Image size 1932x1916: 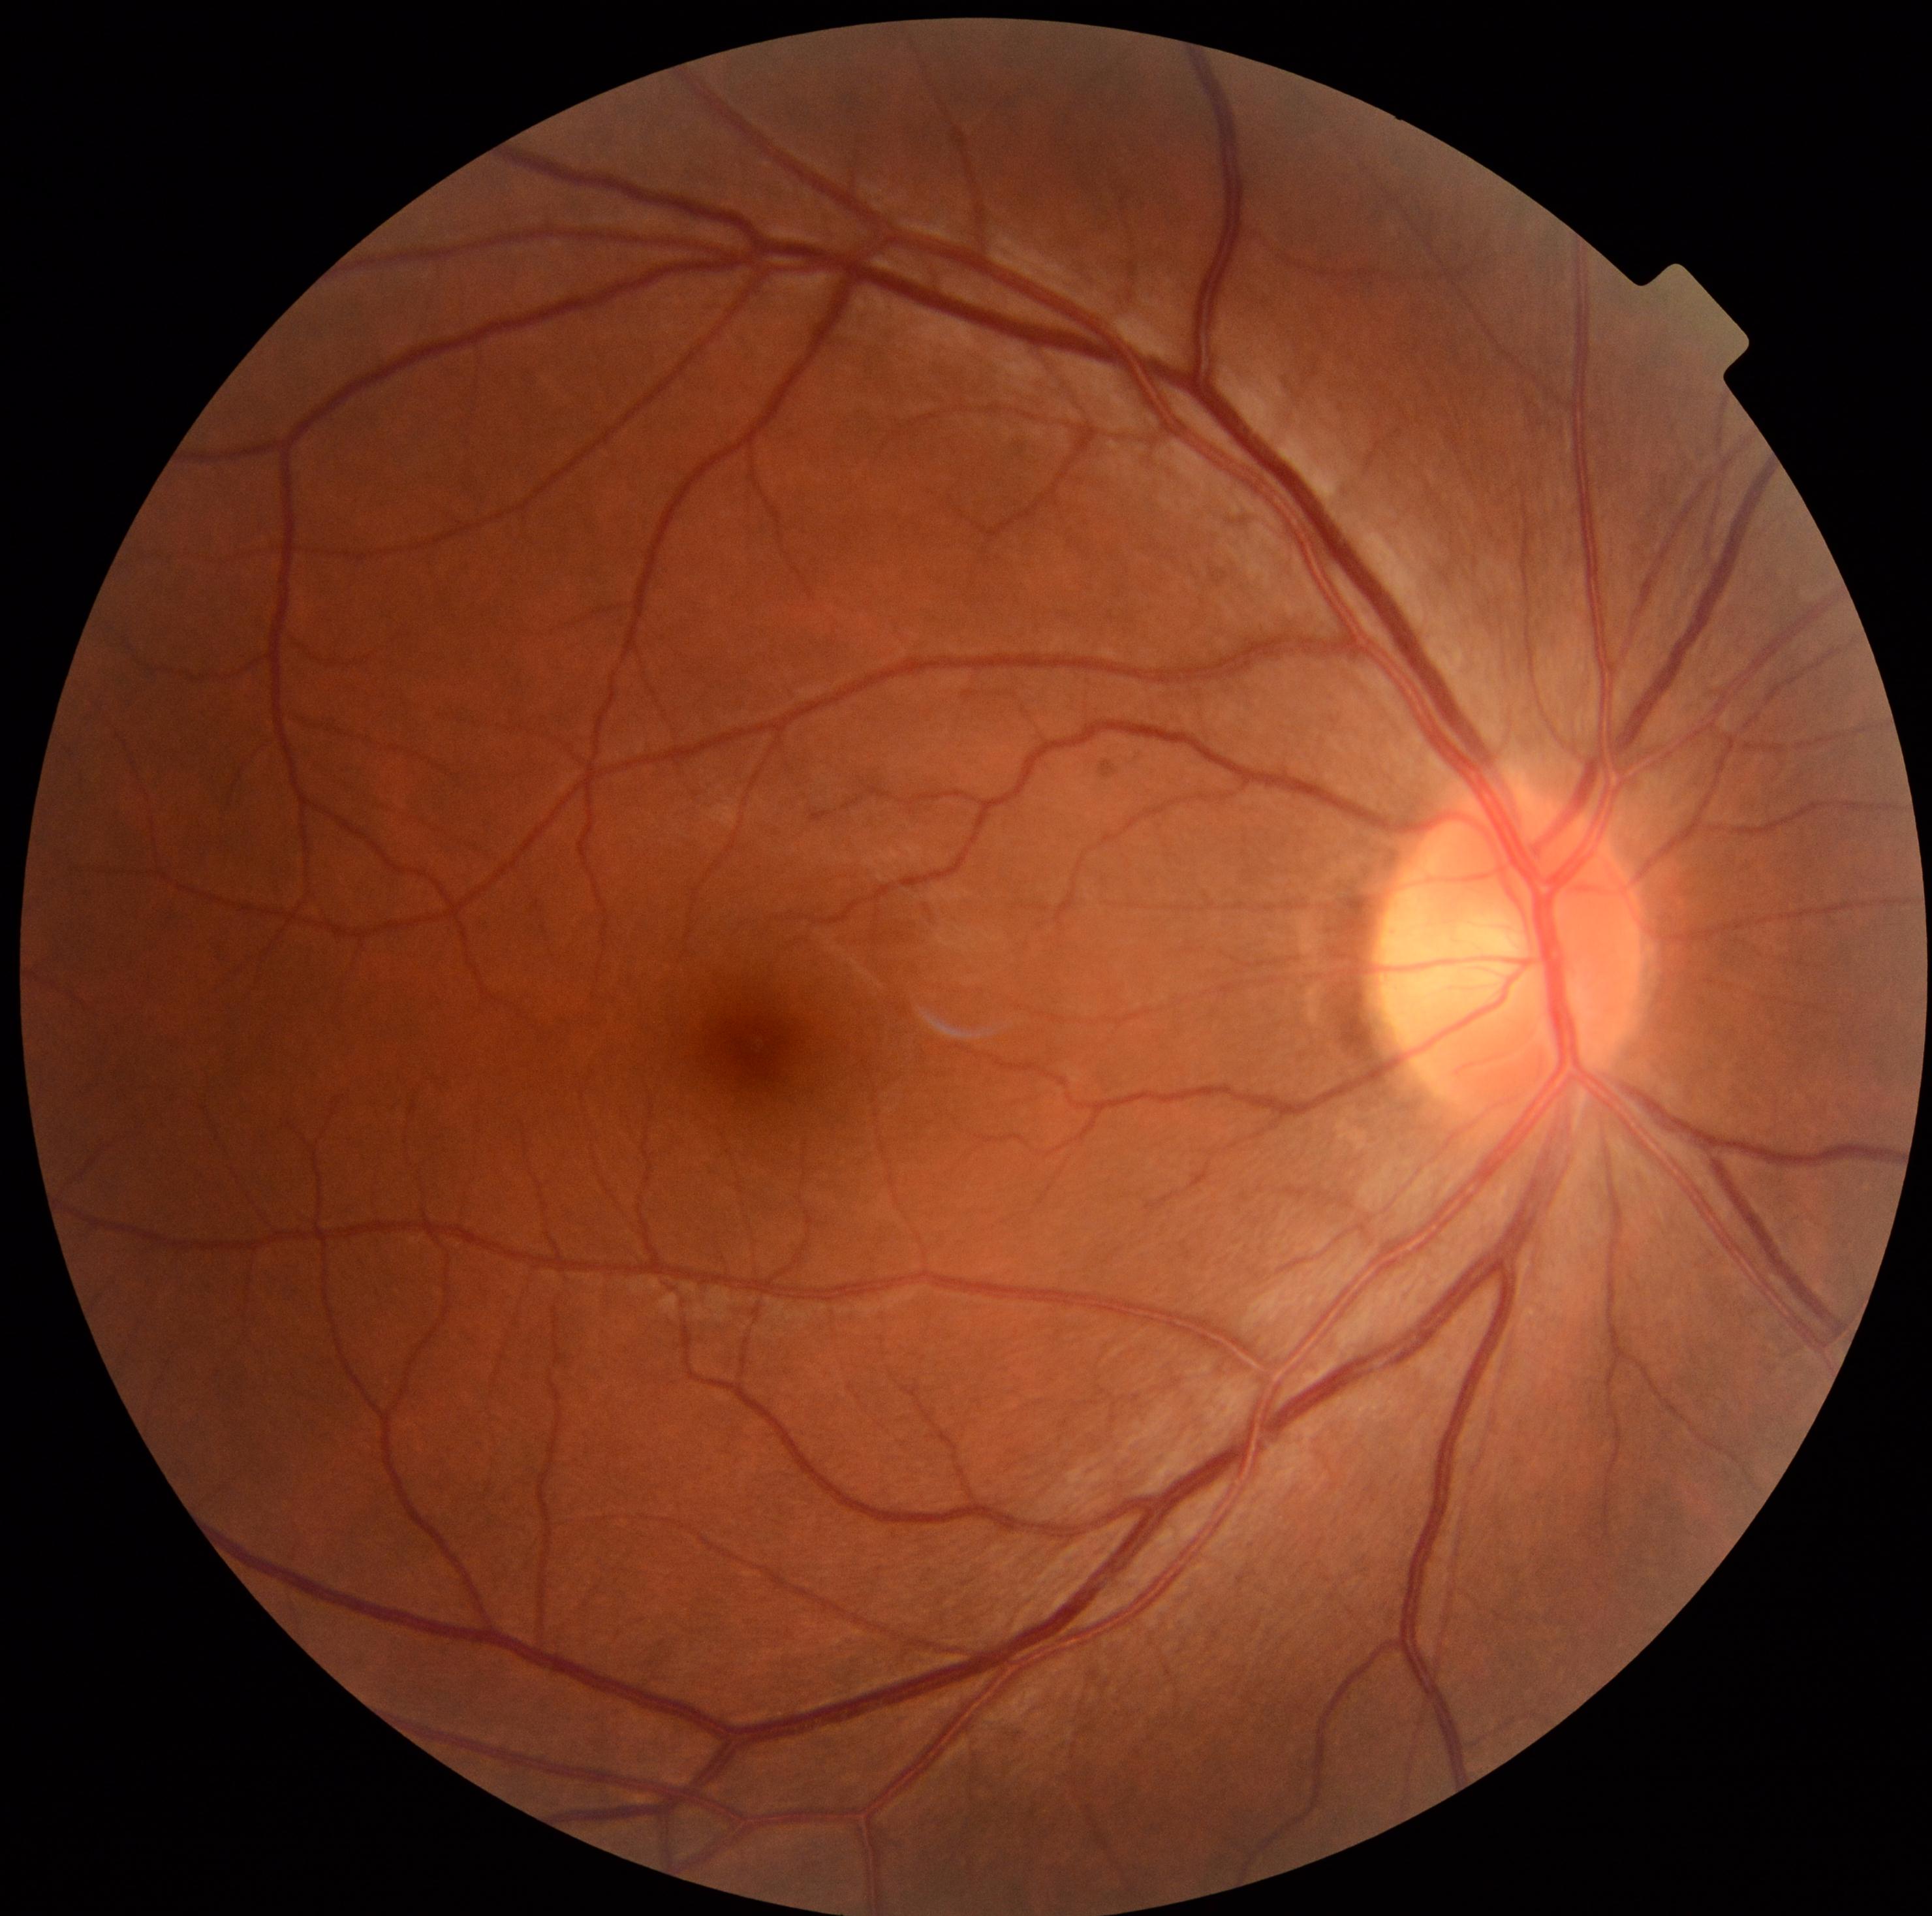
diabetic retinopathy severity = grade 0 (no apparent retinopathy) | DR impression = negative for DR.